Image size 2048x1536 — 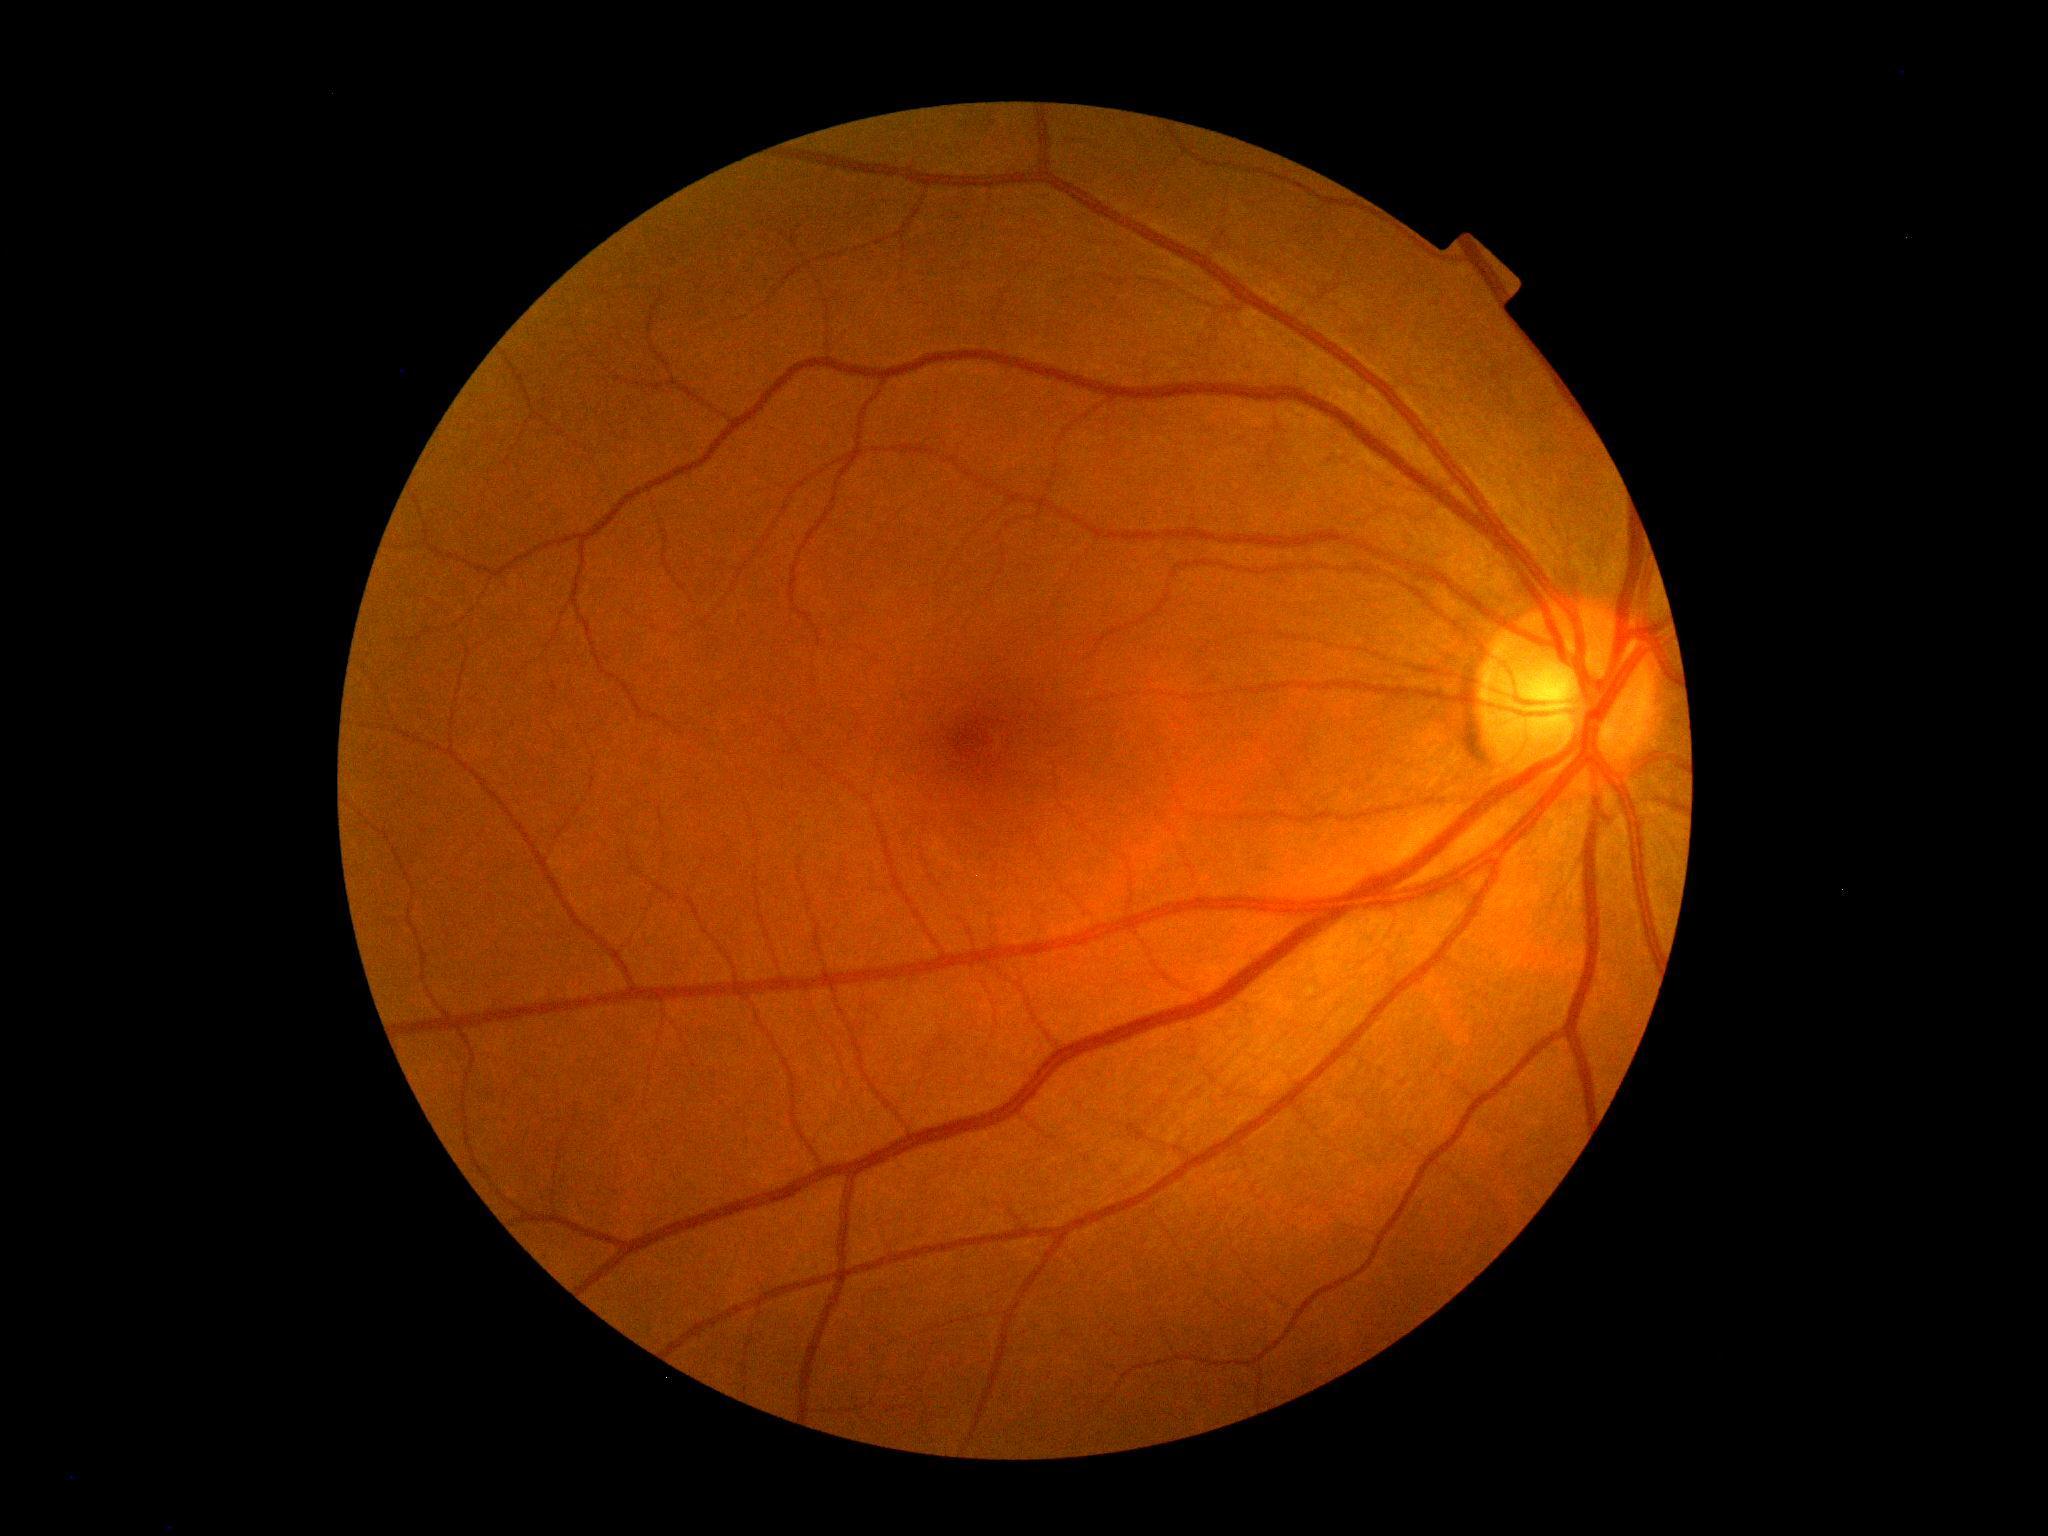 Diabetic retinopathy: no apparent retinopathy (grade 0). No signs of diabetic retinopathy.